Retinal fundus photograph, 45° FOV, image size 2352x1568:
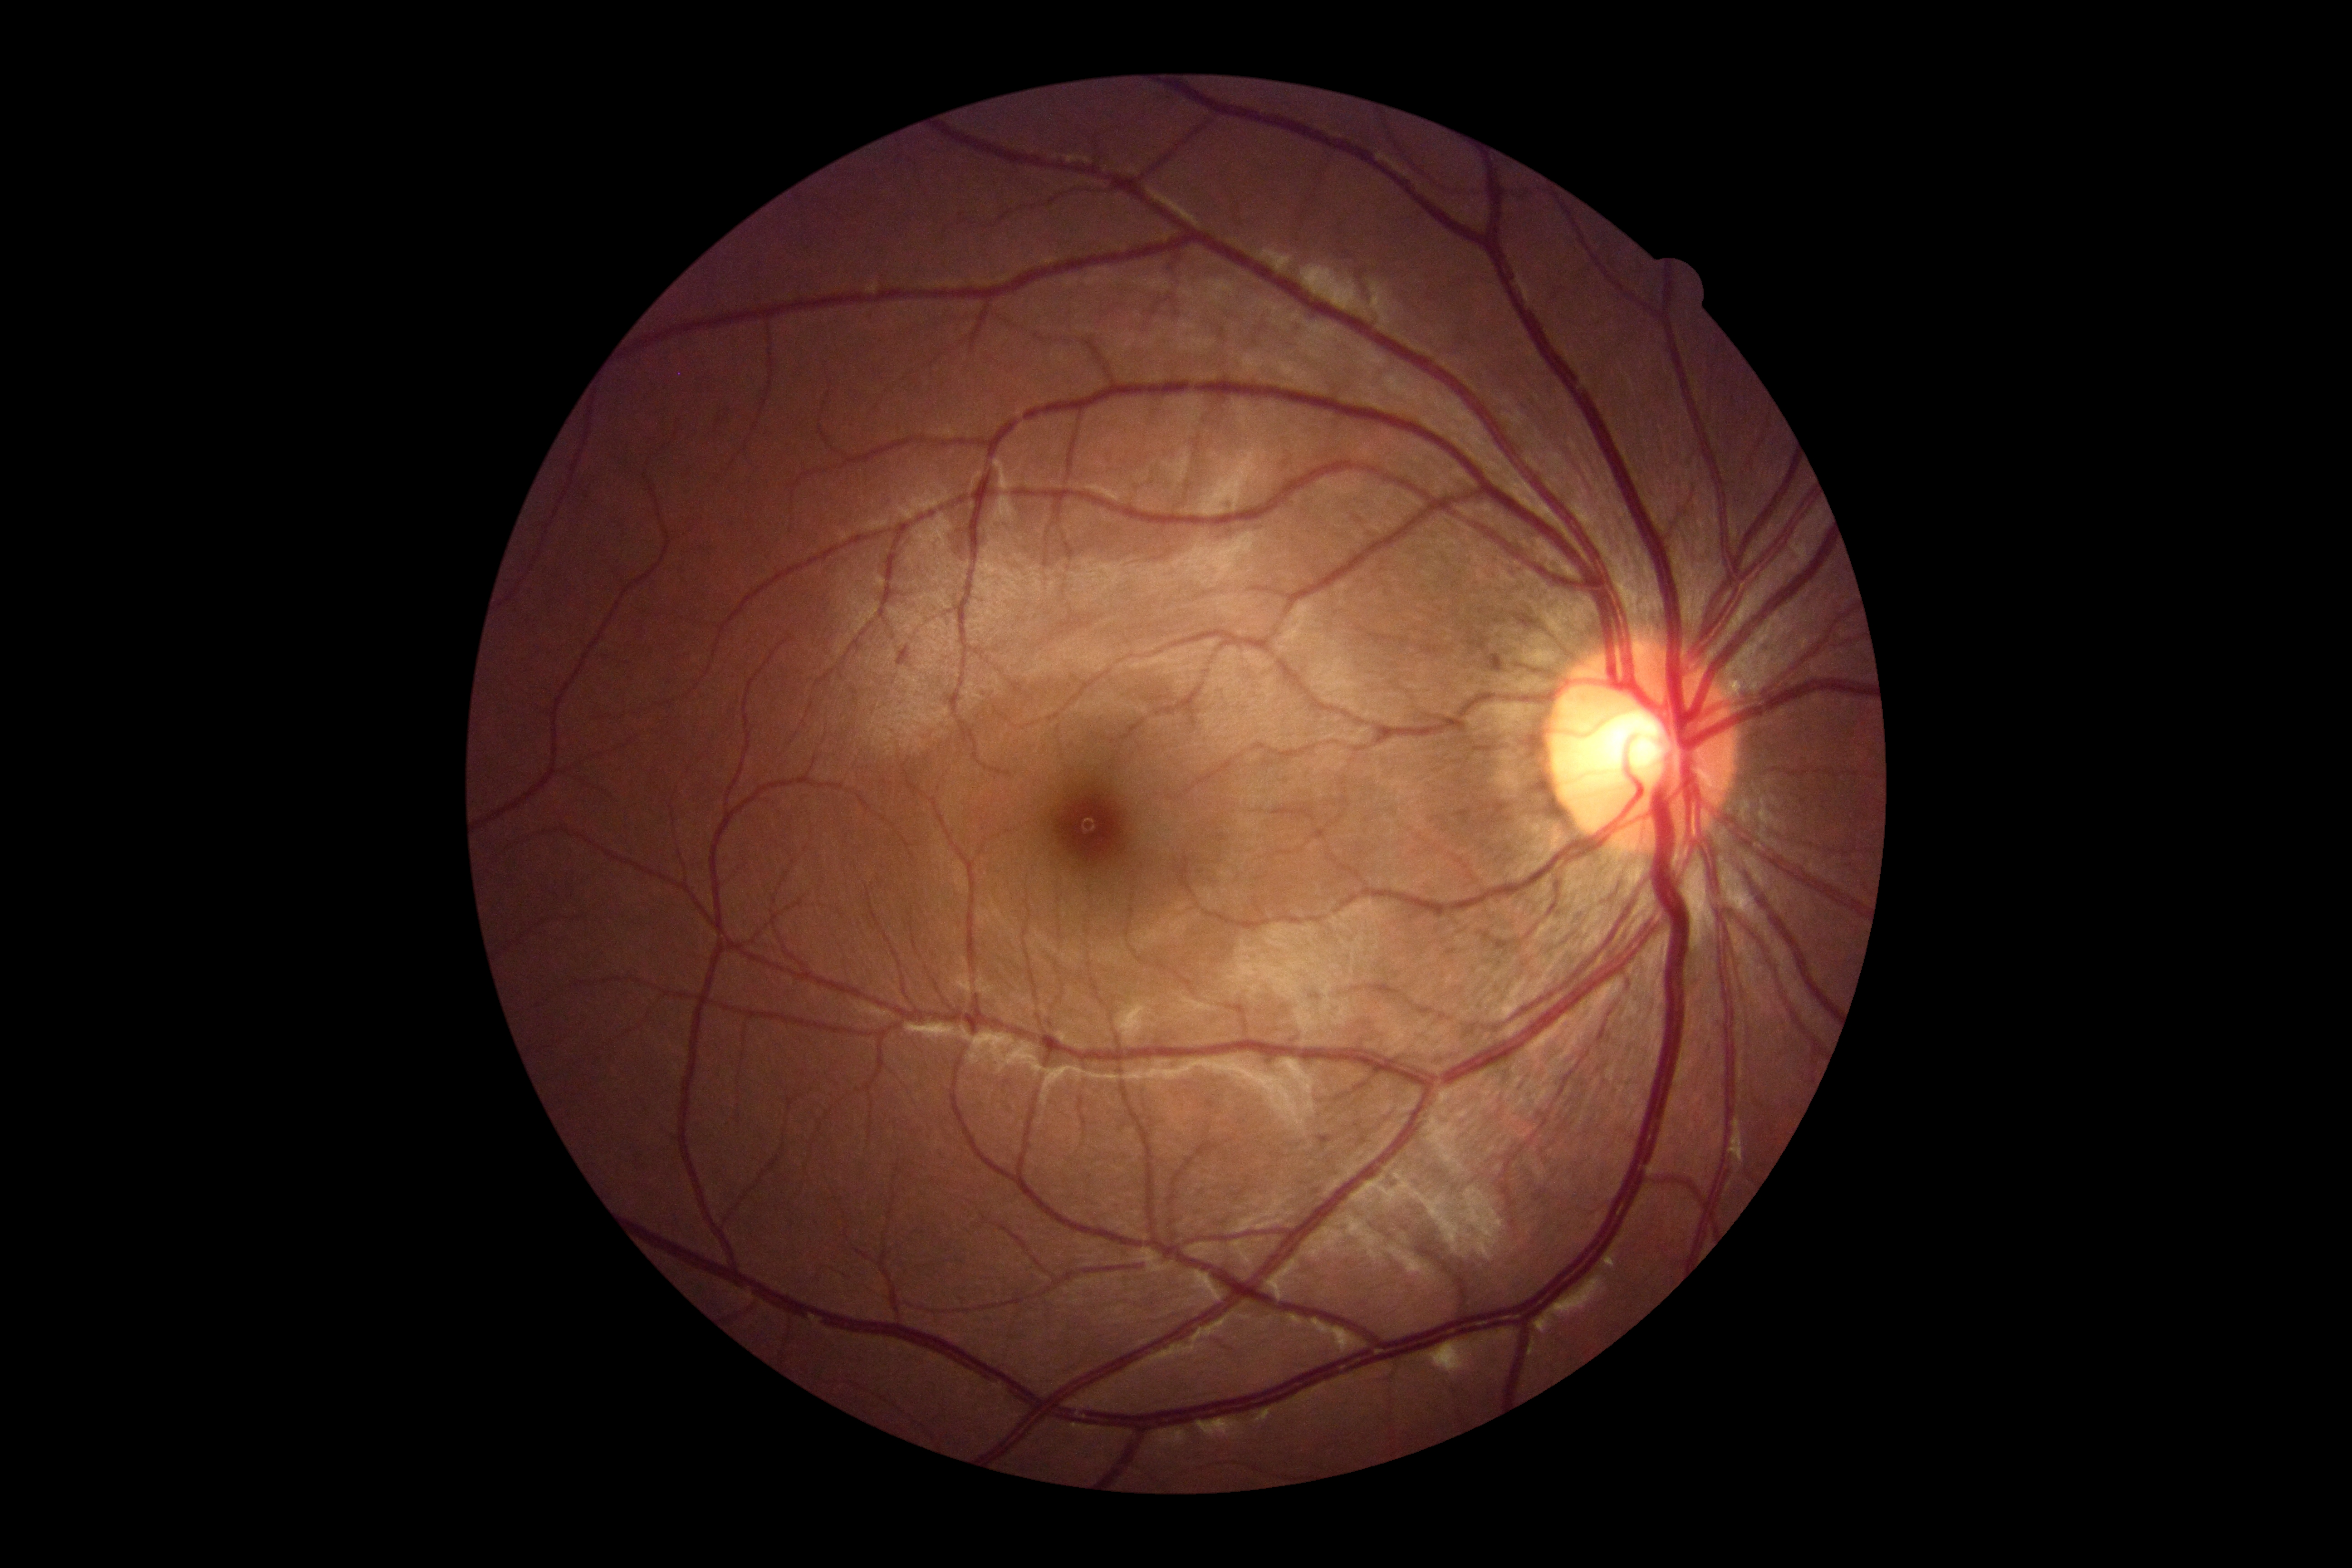

No diabetic retinal disease findings.
DR grade is 0/4.